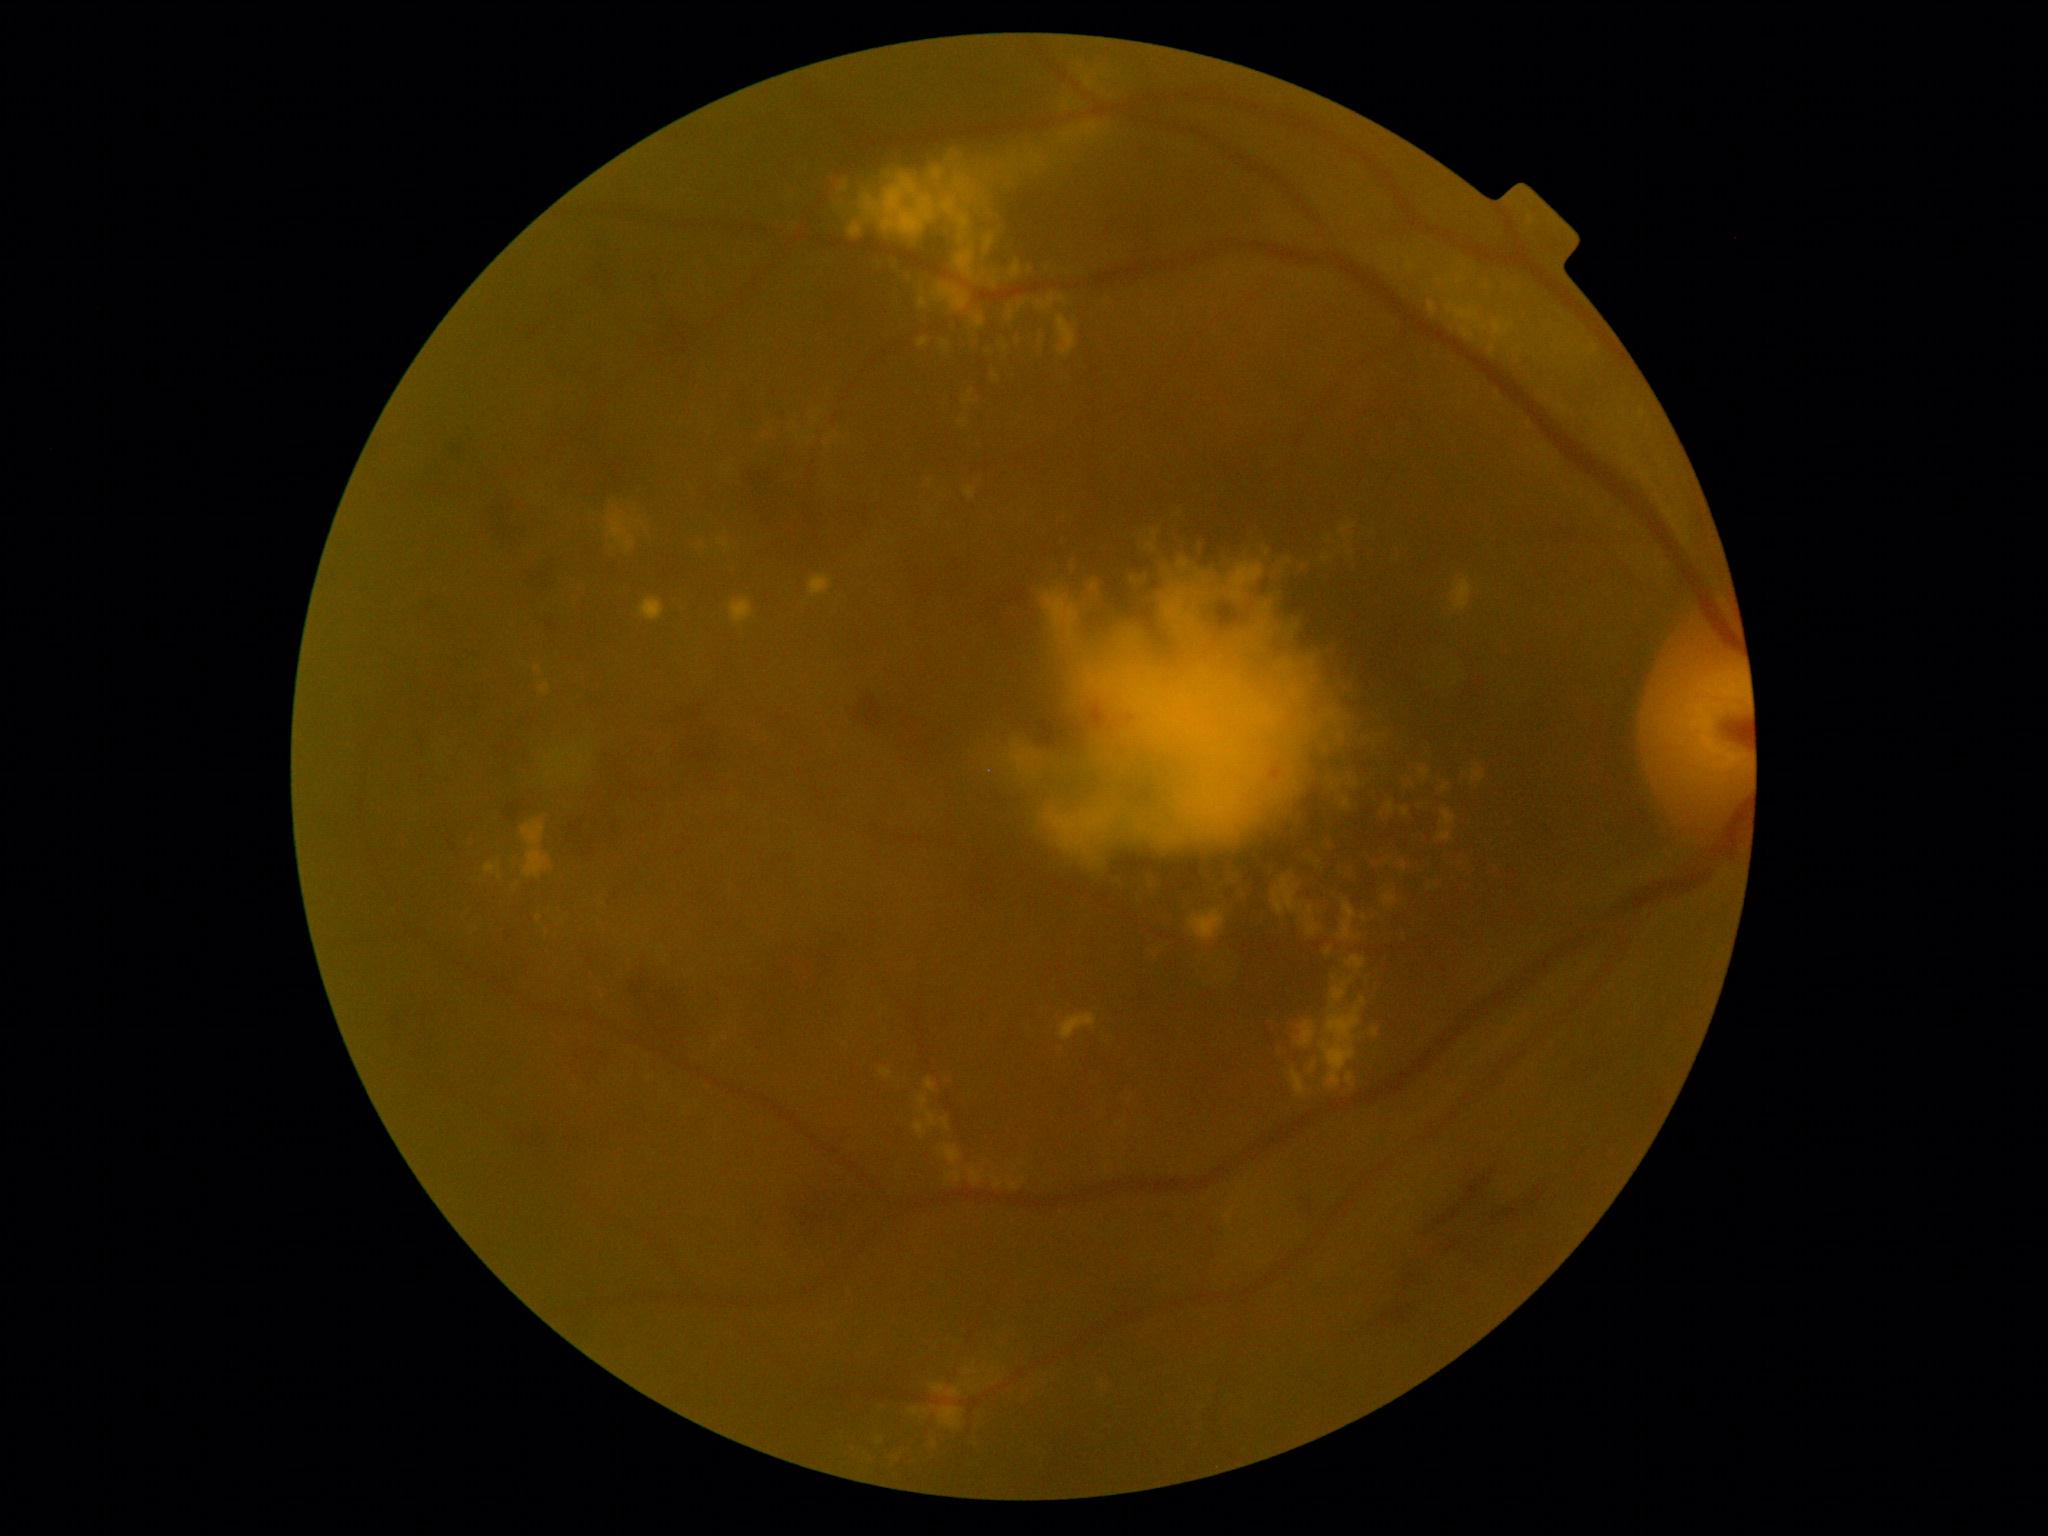

Diabetic retinopathy (DR): 2 — more than just microaneurysms but less than severe NPDR.
Hard exudates (EXs) include <box>609,497,644,535</box>; <box>1129,568,1150,588</box>; <box>974,141,1027,229</box>; <box>984,237,995,255</box>; <box>919,298,928,310</box>; <box>957,321,978,353</box>; <box>719,538,739,555</box>; <box>1330,969,1343,982</box>; <box>1142,529,1152,542</box>; <box>1302,906,1321,936</box>; <box>995,1180,1003,1187</box>; <box>1441,810,1456,826</box>; <box>1337,899,1357,941</box>; <box>909,1408,919,1415</box>; <box>1292,1071,1305,1095</box>; <box>1037,136,1066,176</box>.
Small EXs approximately at 1431, 888; 1014, 1187.